Infant wide-field retinal image
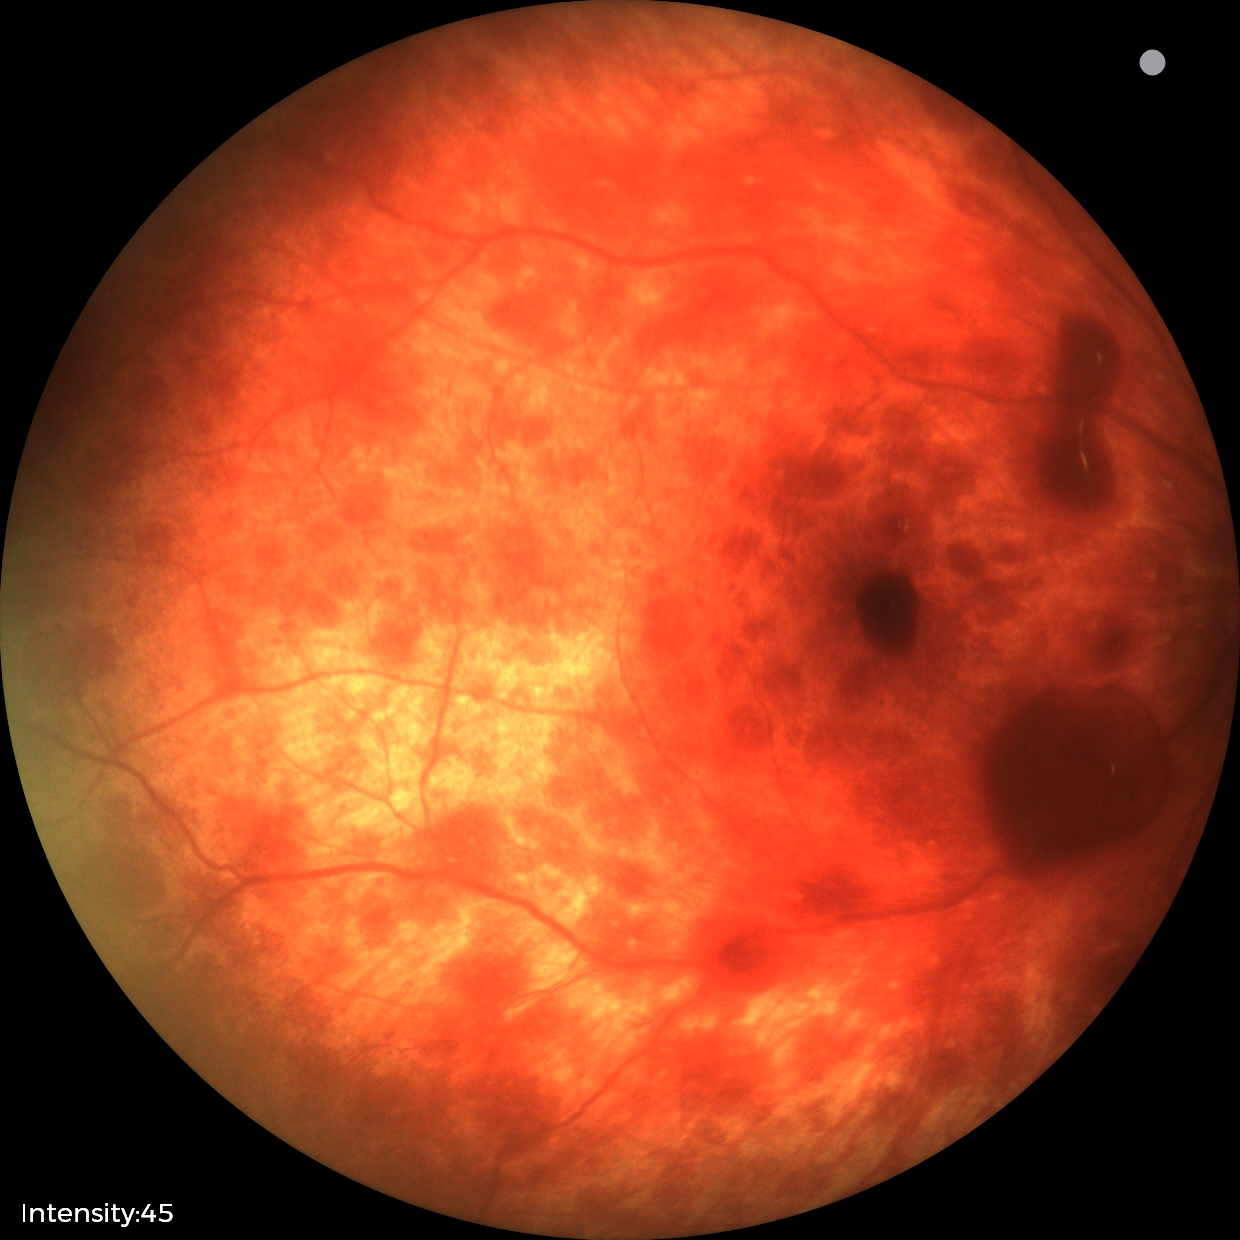 Diagnosis from this screening exam: retinal hemorrhages.